Without pupil dilation — 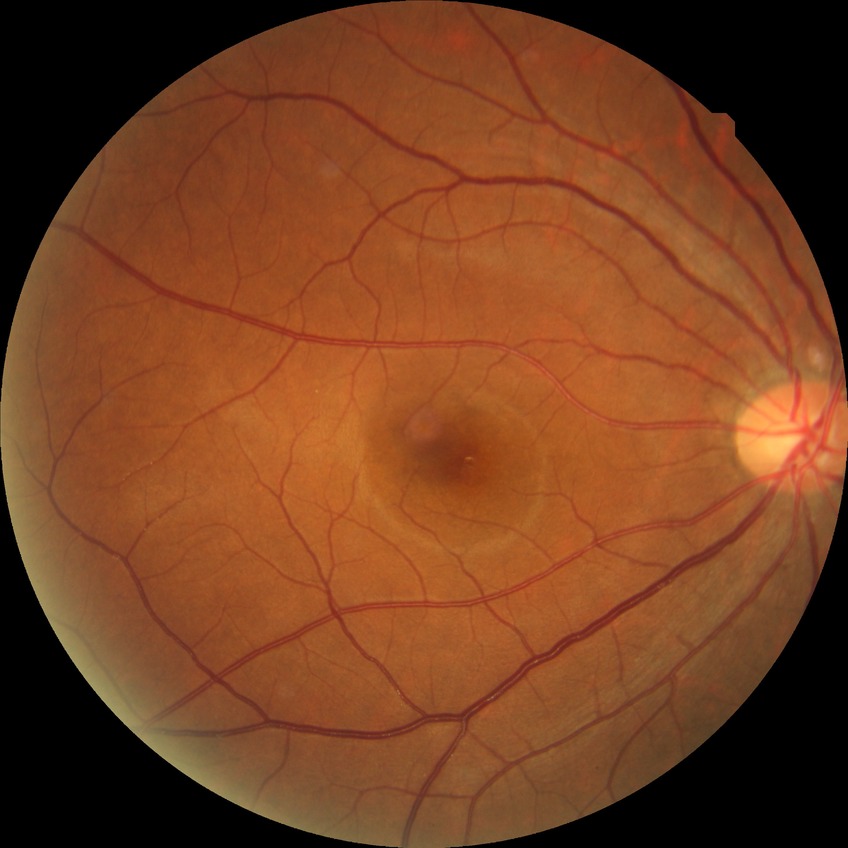 Modified Davis grading is no diabetic retinopathy.